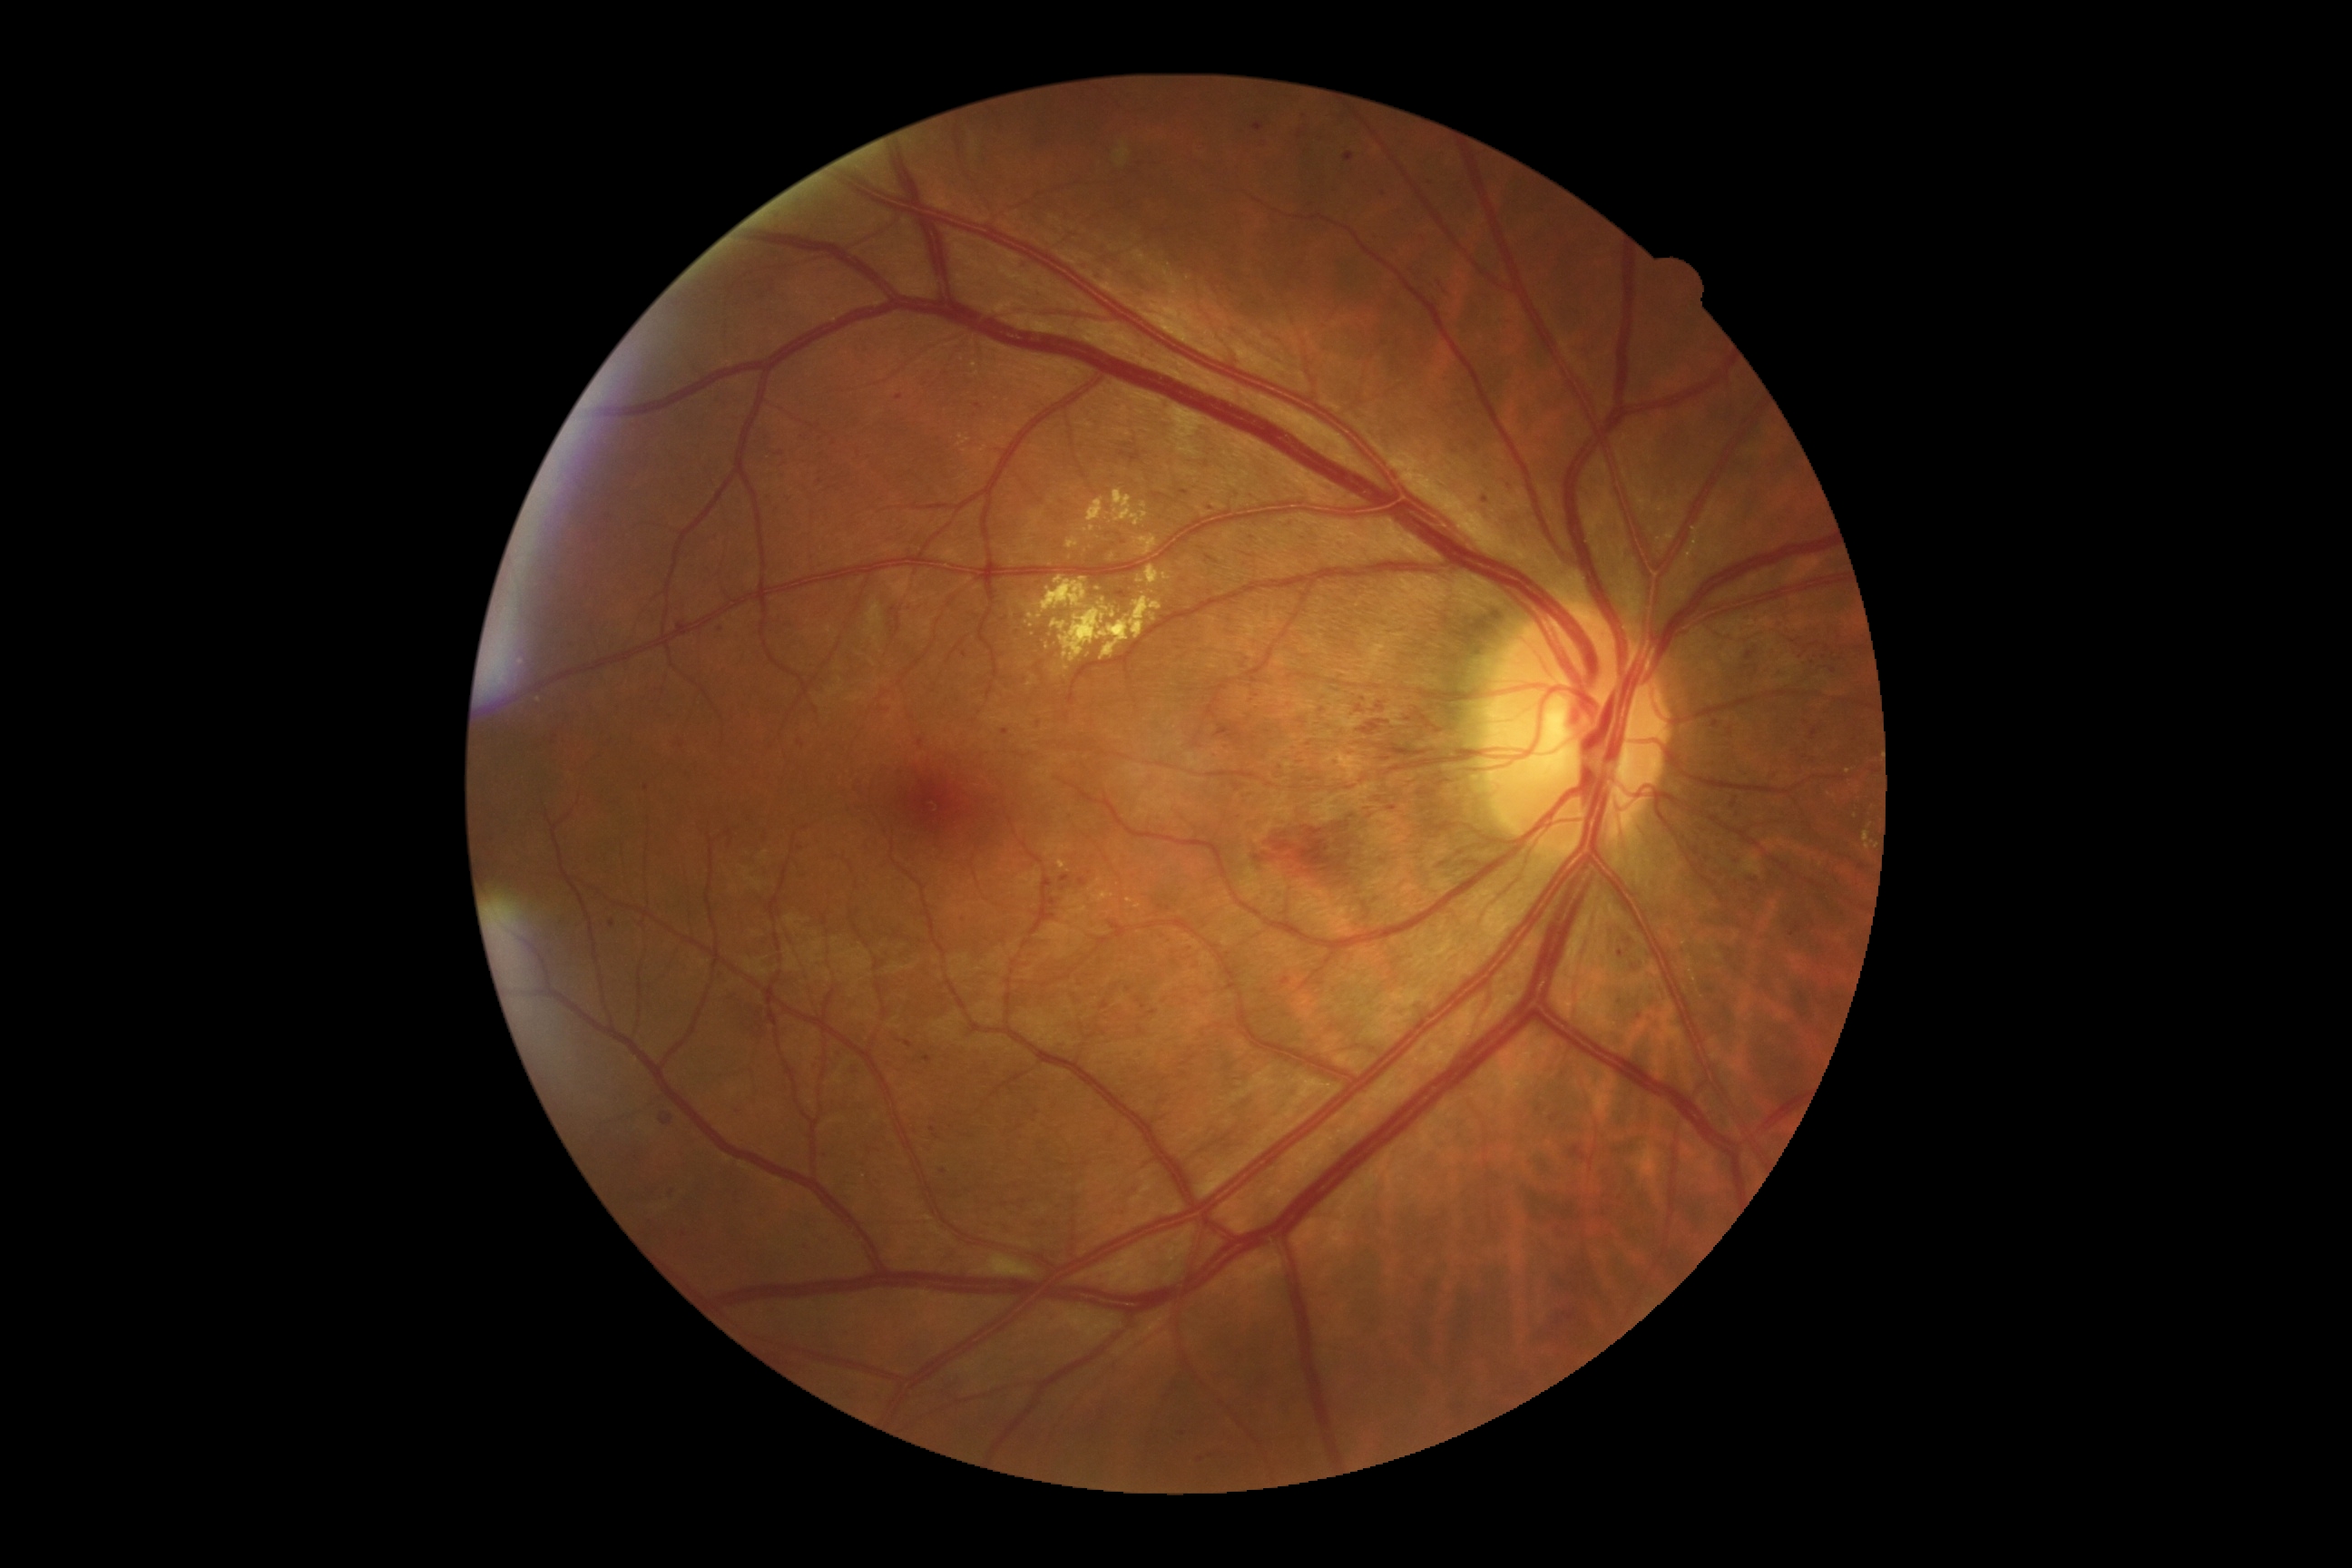 Diabetic retinopathy (DR) is severe NPDR (grade 3) — more than 20 intraretinal hemorrhages in each of 4 quadrants, definite venous beading in 2 or more quadrants, or prominent intraretinal microvascular abnormalities in 1 or more quadrants, with no signs of proliferative retinopathy. Hemorrhages (HEs) (partial list) at {"x1": 769, "y1": 277, "x2": 778, "y2": 297}, {"x1": 814, "y1": 435, "x2": 825, "y2": 442}, {"x1": 1017, "y1": 260, "x2": 1028, "y2": 270}, {"x1": 1467, "y1": 442, "x2": 1480, "y2": 453}, {"x1": 1801, "y1": 721, "x2": 1821, "y2": 743}, {"x1": 1373, "y1": 233, "x2": 1384, "y2": 242}, {"x1": 832, "y1": 1050, "x2": 843, "y2": 1061}, {"x1": 847, "y1": 1063, "x2": 861, "y2": 1077}, {"x1": 1306, "y1": 184, "x2": 1315, "y2": 191}, {"x1": 1707, "y1": 716, "x2": 1725, "y2": 732}, {"x1": 905, "y1": 1041, "x2": 914, "y2": 1048}, {"x1": 1244, "y1": 807, "x2": 1393, "y2": 899}, {"x1": 1220, "y1": 745, "x2": 1230, "y2": 750}. Small HEs approximately at <pt>937,438</pt>, <pt>1455,451</pt>, <pt>1039,725</pt>, <pt>1207,465</pt>, <pt>1129,991</pt>. Hard exudates (EXs) (partial list) at {"x1": 1660, "y1": 505, "x2": 1665, "y2": 513}, {"x1": 1066, "y1": 538, "x2": 1081, "y2": 549}, {"x1": 1083, "y1": 525, "x2": 1095, "y2": 533}, {"x1": 1028, "y1": 614, "x2": 1043, "y2": 620}, {"x1": 1026, "y1": 622, "x2": 1034, "y2": 629}, {"x1": 1088, "y1": 498, "x2": 1110, "y2": 524}, {"x1": 1101, "y1": 607, "x2": 1110, "y2": 612}, {"x1": 1093, "y1": 892, "x2": 1115, "y2": 903}, {"x1": 1070, "y1": 906, "x2": 1088, "y2": 916}, {"x1": 1035, "y1": 576, "x2": 1088, "y2": 612}. Small EXs approximately at <pt>1113,557</pt>, <pt>1129,901</pt>, <pt>1848,772</pt>, <pt>1066,669</pt>.